Image size 848x848; nonmydriatic fundus photograph; DR severity per modified Davis staging; posterior pole photograph; FOV: 45 degrees; NIDEK AFC-230 fundus camera.
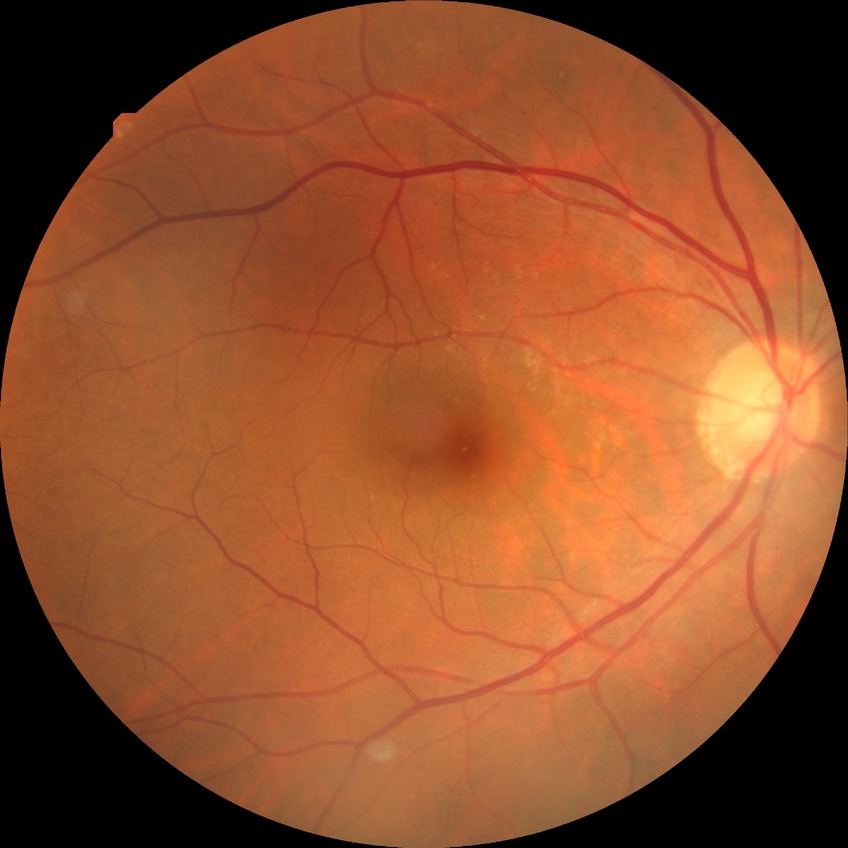
{"davis_grade": "no diabetic retinopathy"}